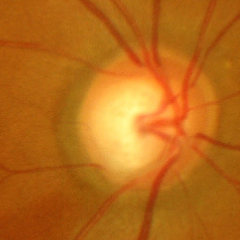

Diagnosis = severe glaucomatous damage.